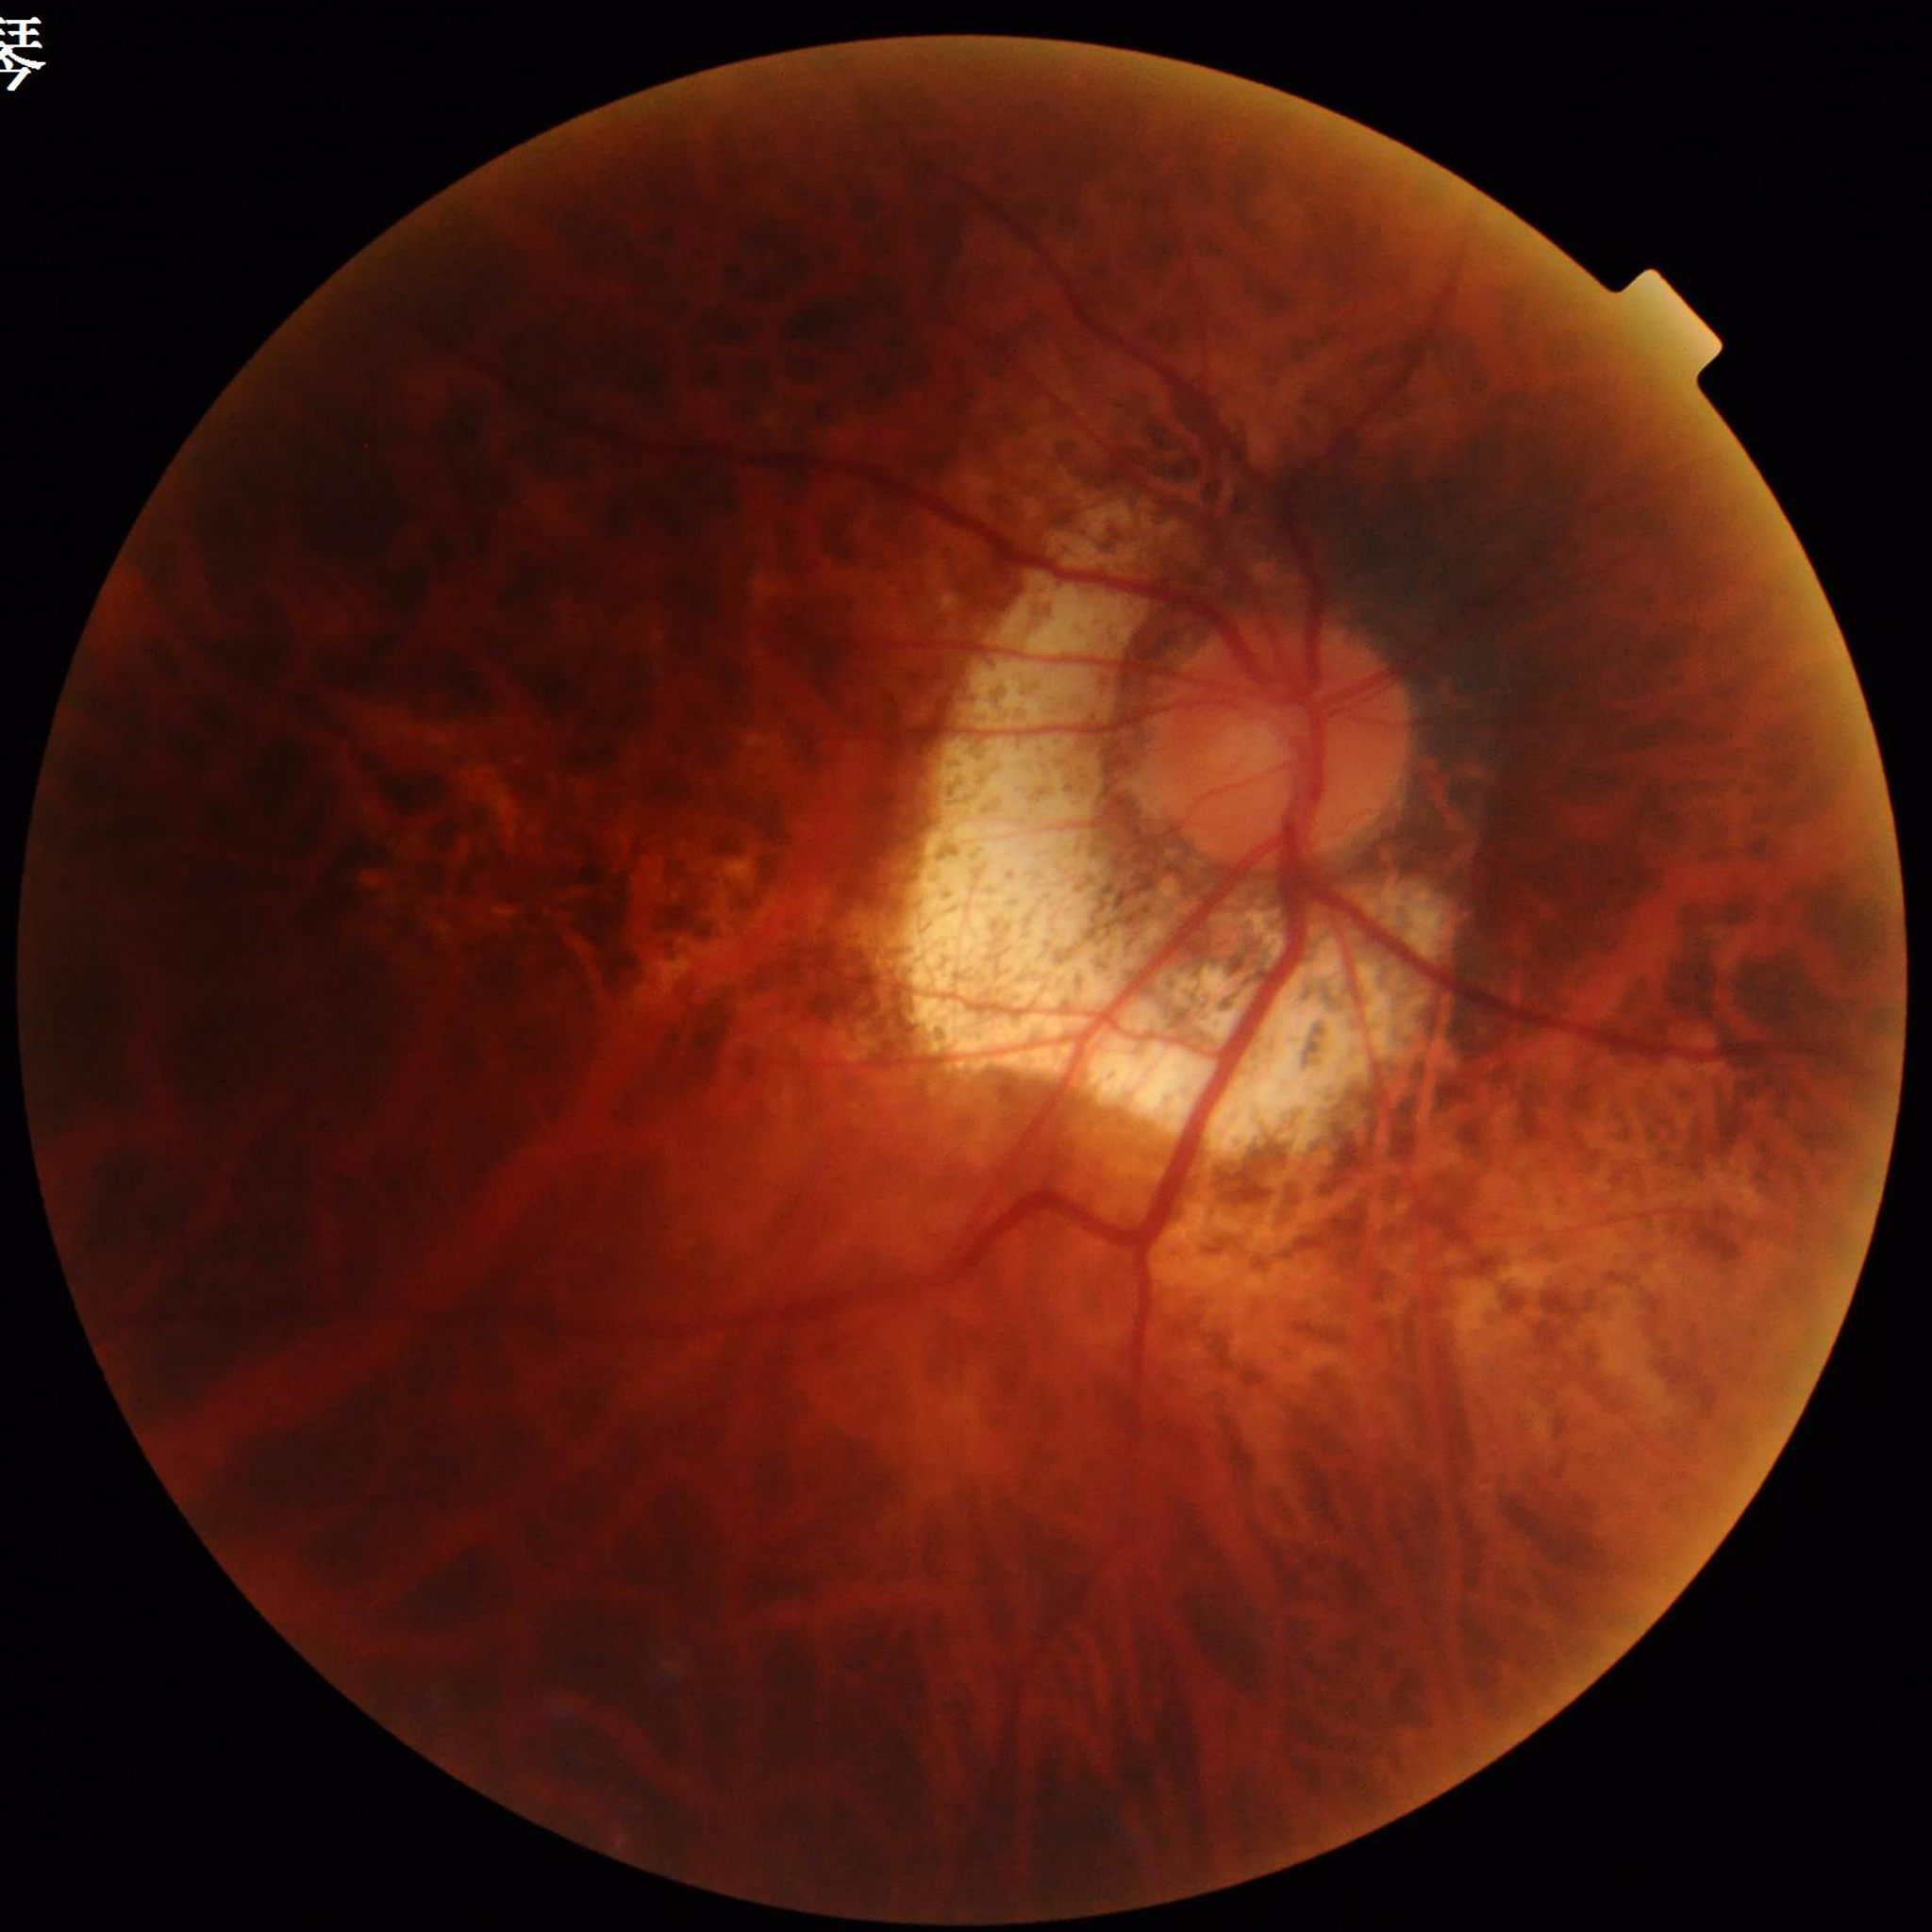

This fundus photograph is from a patient diagnosed with diabetic retinopathy. Quality assessment: suboptimal — illumination/color distortion.